2352x1568px
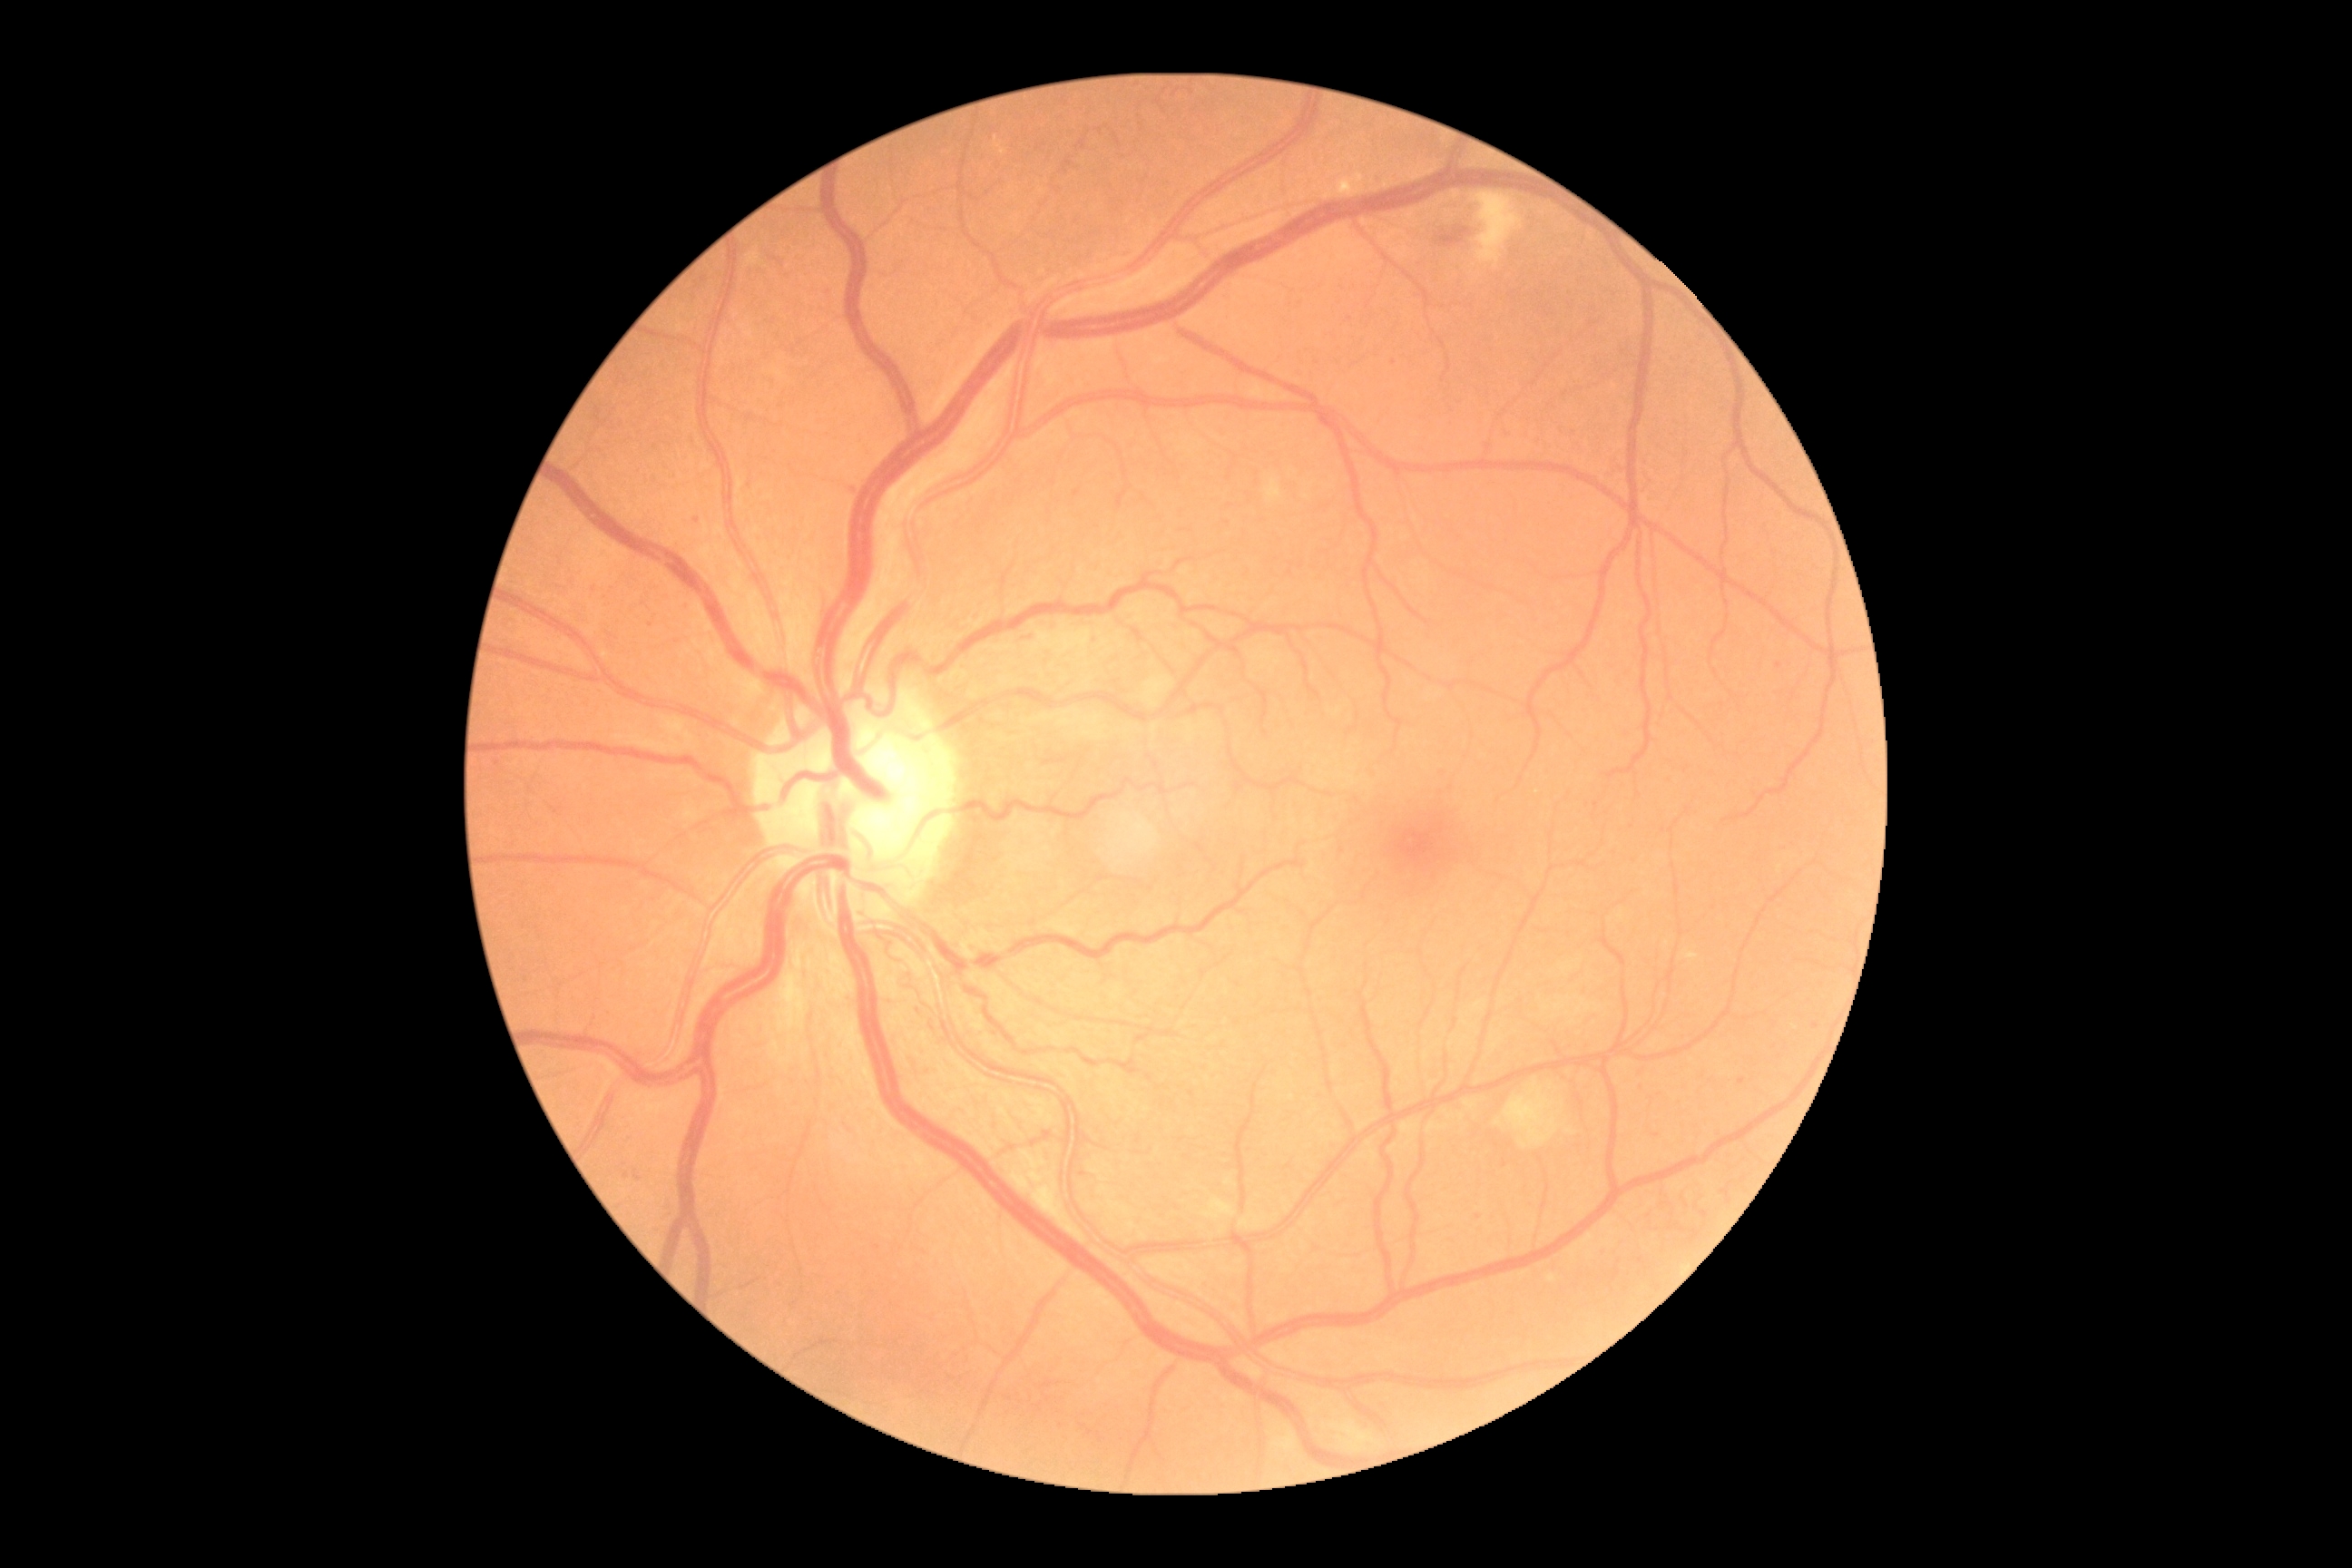
{"partial":true,"dr_grade":2,"lesions":{"ex":[[1342,181,1353,193],[1683,950,1698,961]],"ma":[[1738,1077,1745,1086],[1367,770,1377,779],[634,1171,640,1181]],"ma_small_centers":[[1394,363],[697,521],[1505,1164],[1479,1217],[1641,1261],[1441,772],[498,763],[750,486],[1597,806],[1779,666],[1639,1090],[650,625],[626,1176],[1816,1025]],"he":[[1019,632,1039,643],[1438,228,1469,248]],"se":[[745,248,761,268],[1144,676,1173,709],[1266,478,1282,504],[1331,1424,1382,1453],[1504,1083,1562,1148],[1475,193,1524,266]]}}